DR severity per modified Davis staging.
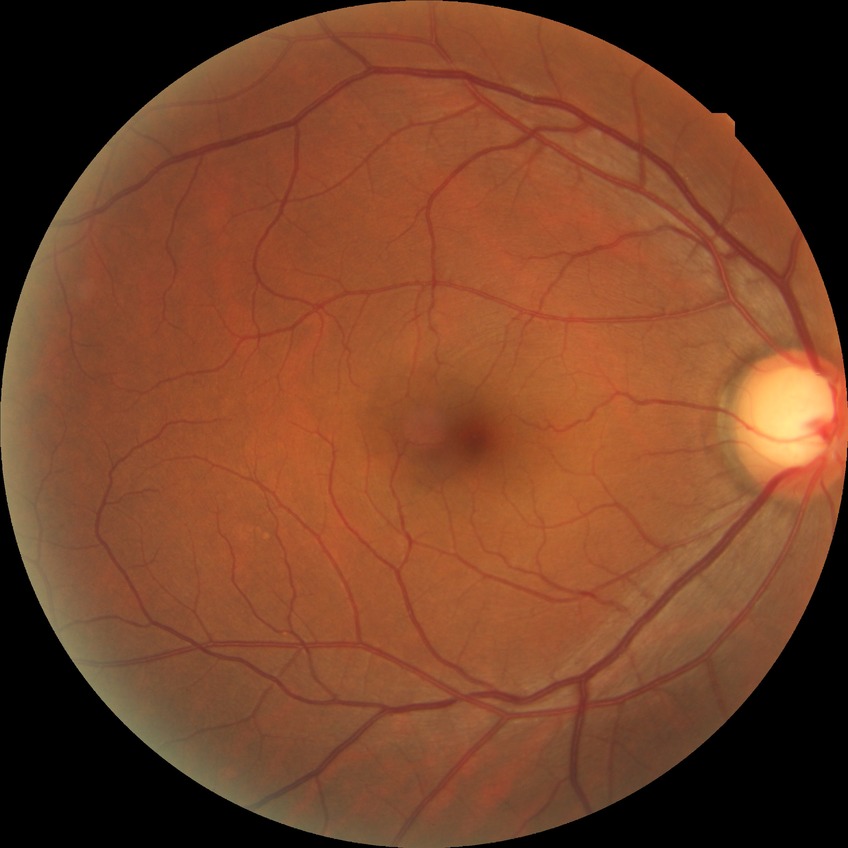

Diabetic retinopathy (DR): NDR (no diabetic retinopathy).